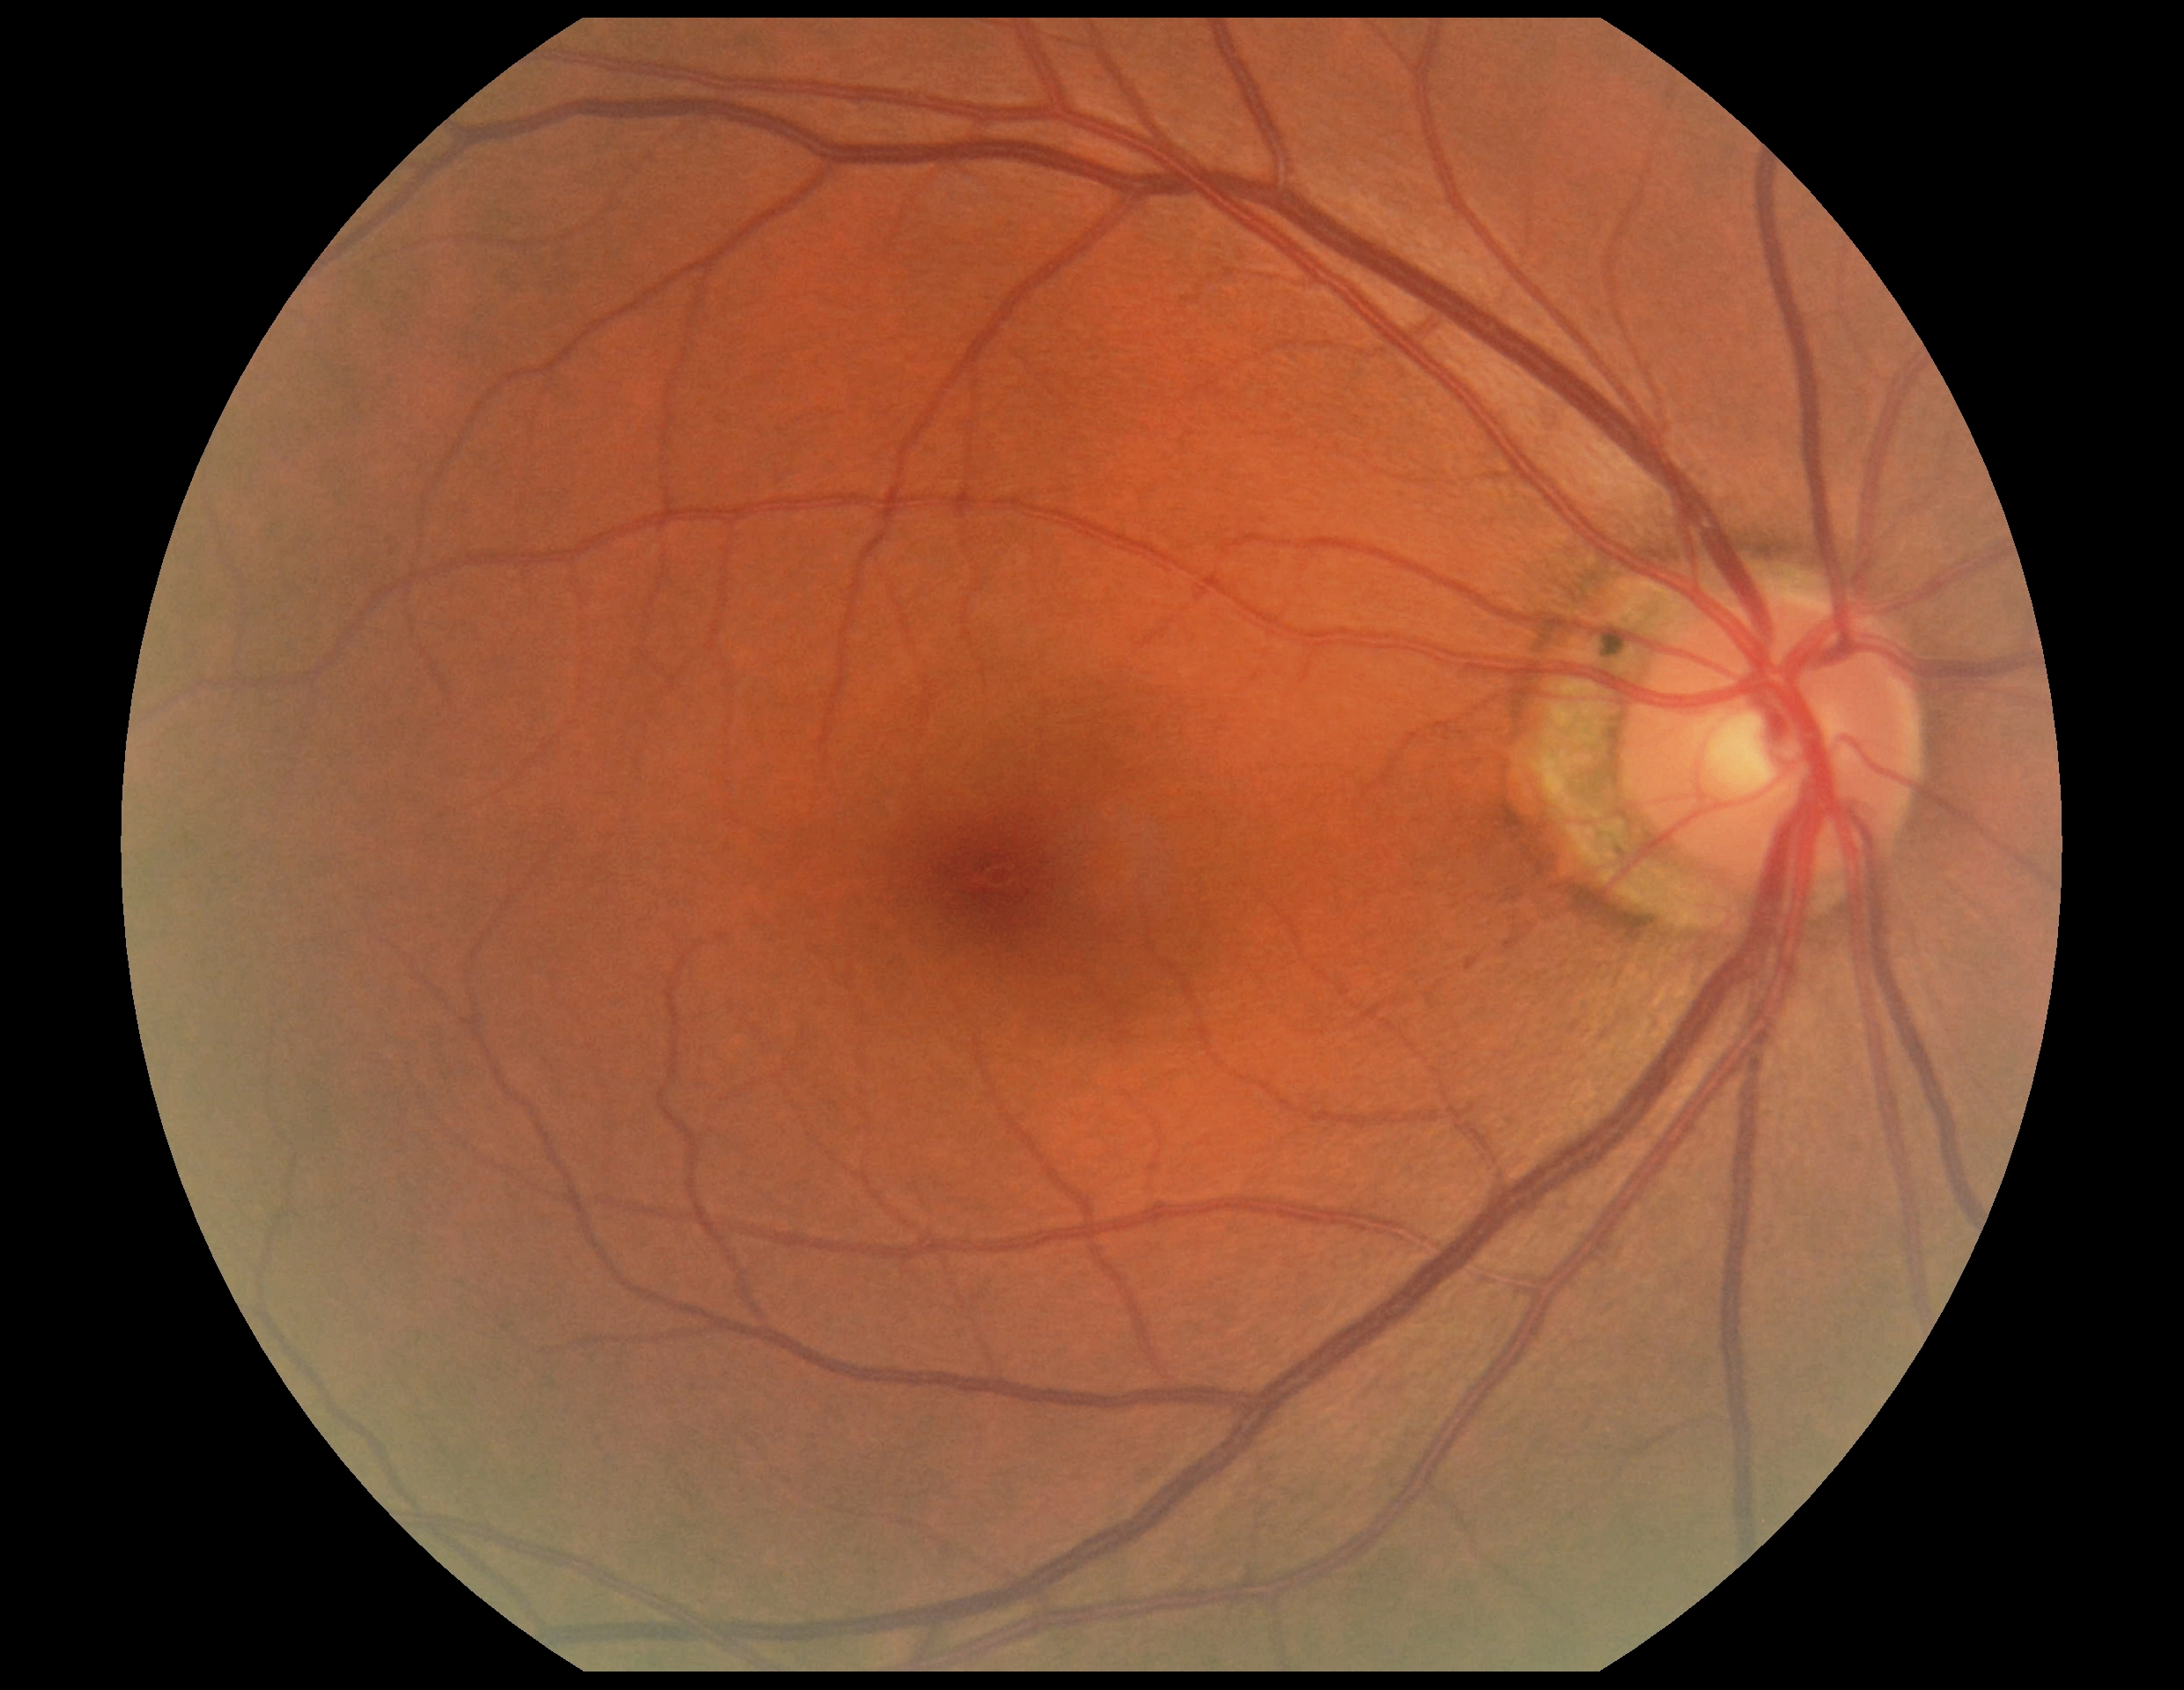

DR stage is no apparent diabetic retinopathy (grade 0).